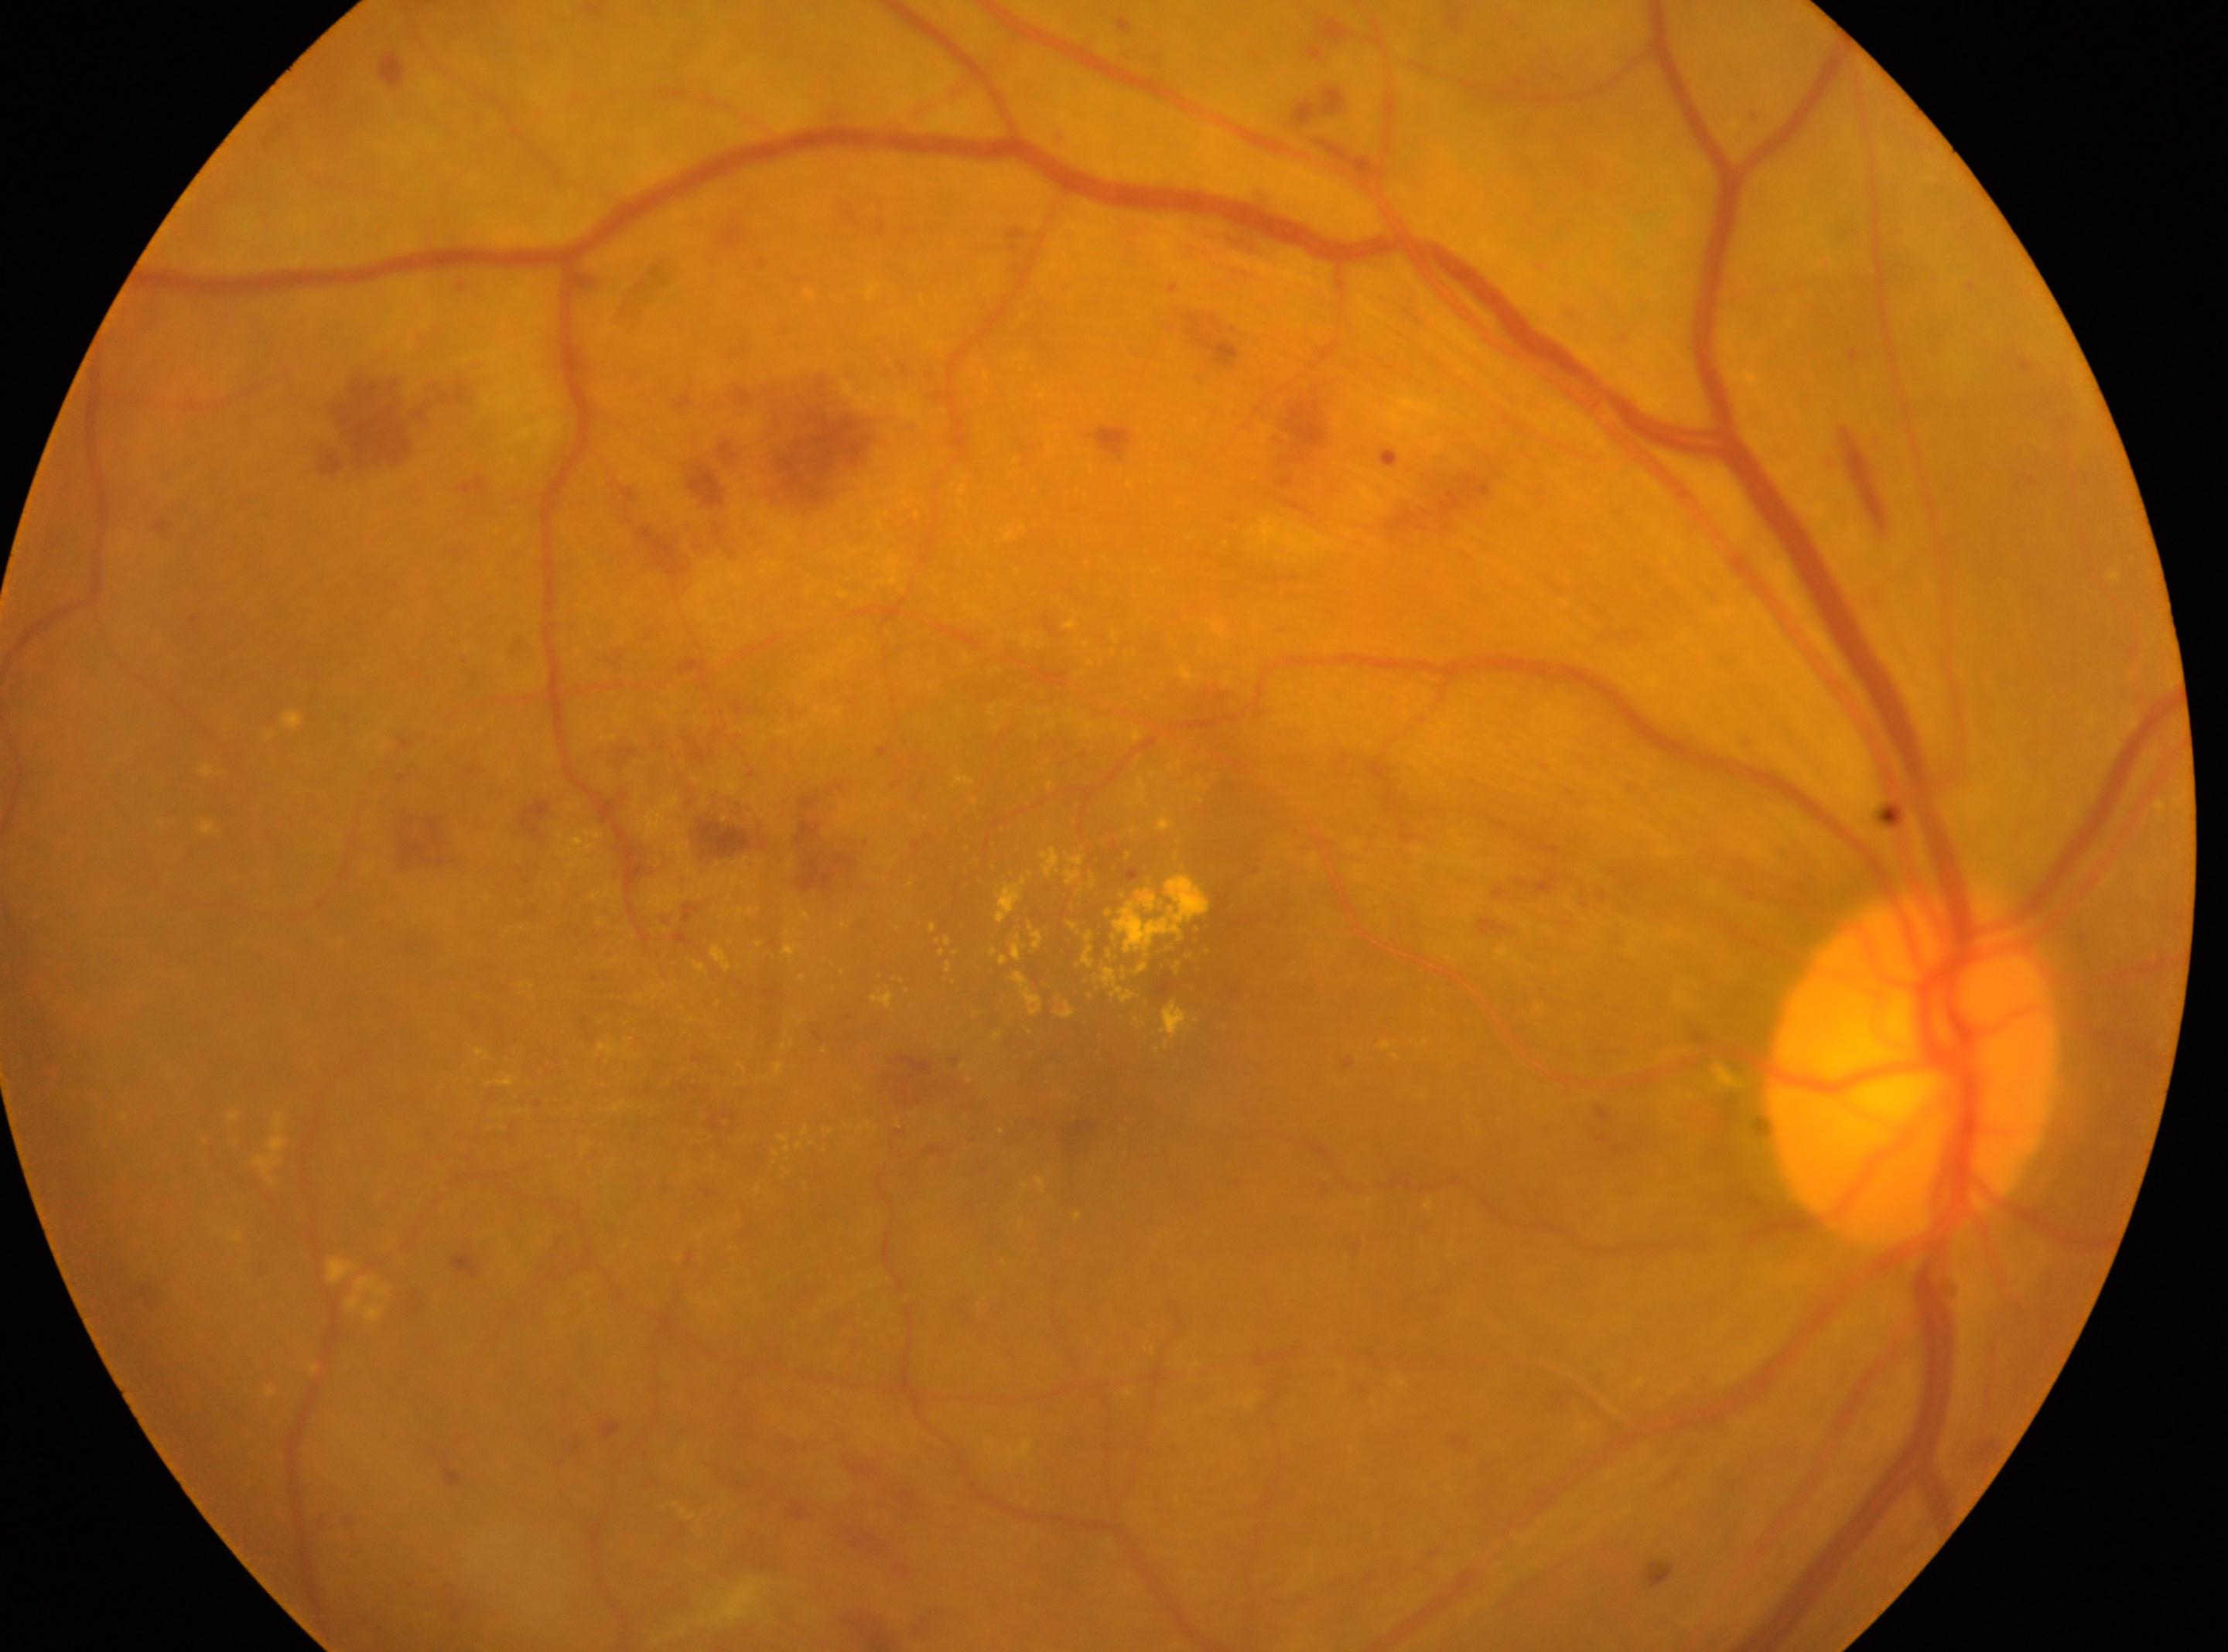

Fovea: (1080,1066).
Diabetic retinopathy (DR): severe NPDR (grade 3) — more than 20 intraretinal hemorrhages in each of 4 quadrants, definite venous beading in 2 or more quadrants, or prominent intraretinal microvascular abnormalities in 1 or more quadrants, with no signs of proliferative retinopathy.
Optic nerve head located at (1909,1067).
Eye: the right eye.